848x848px. Davis DR grading.
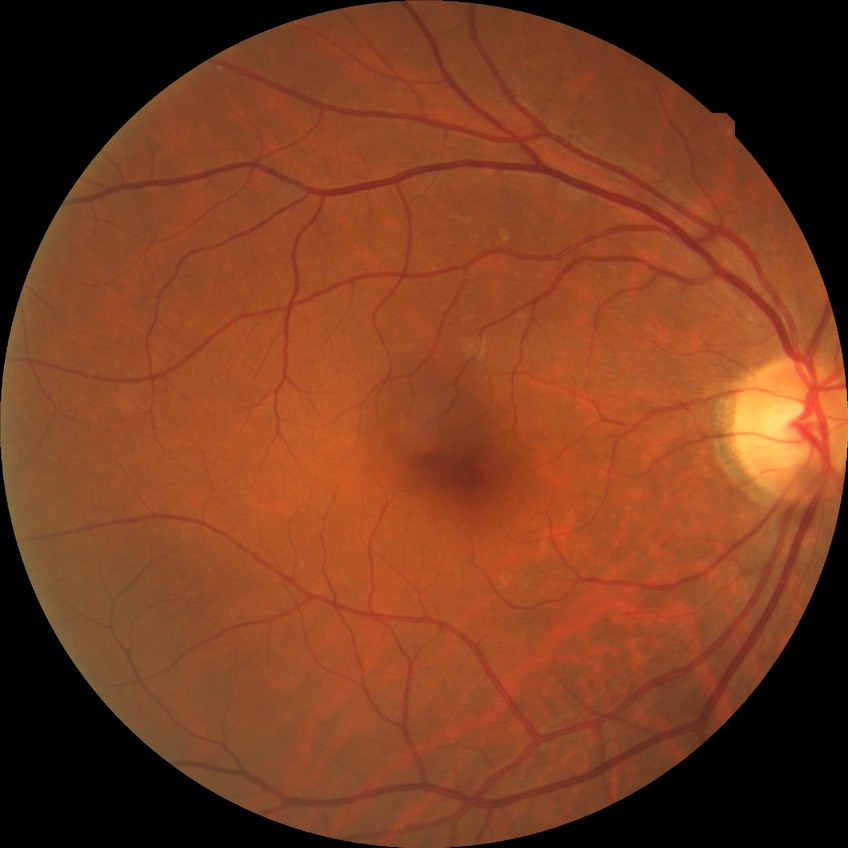 DR impression: no signs of DR
DR stage: NDR